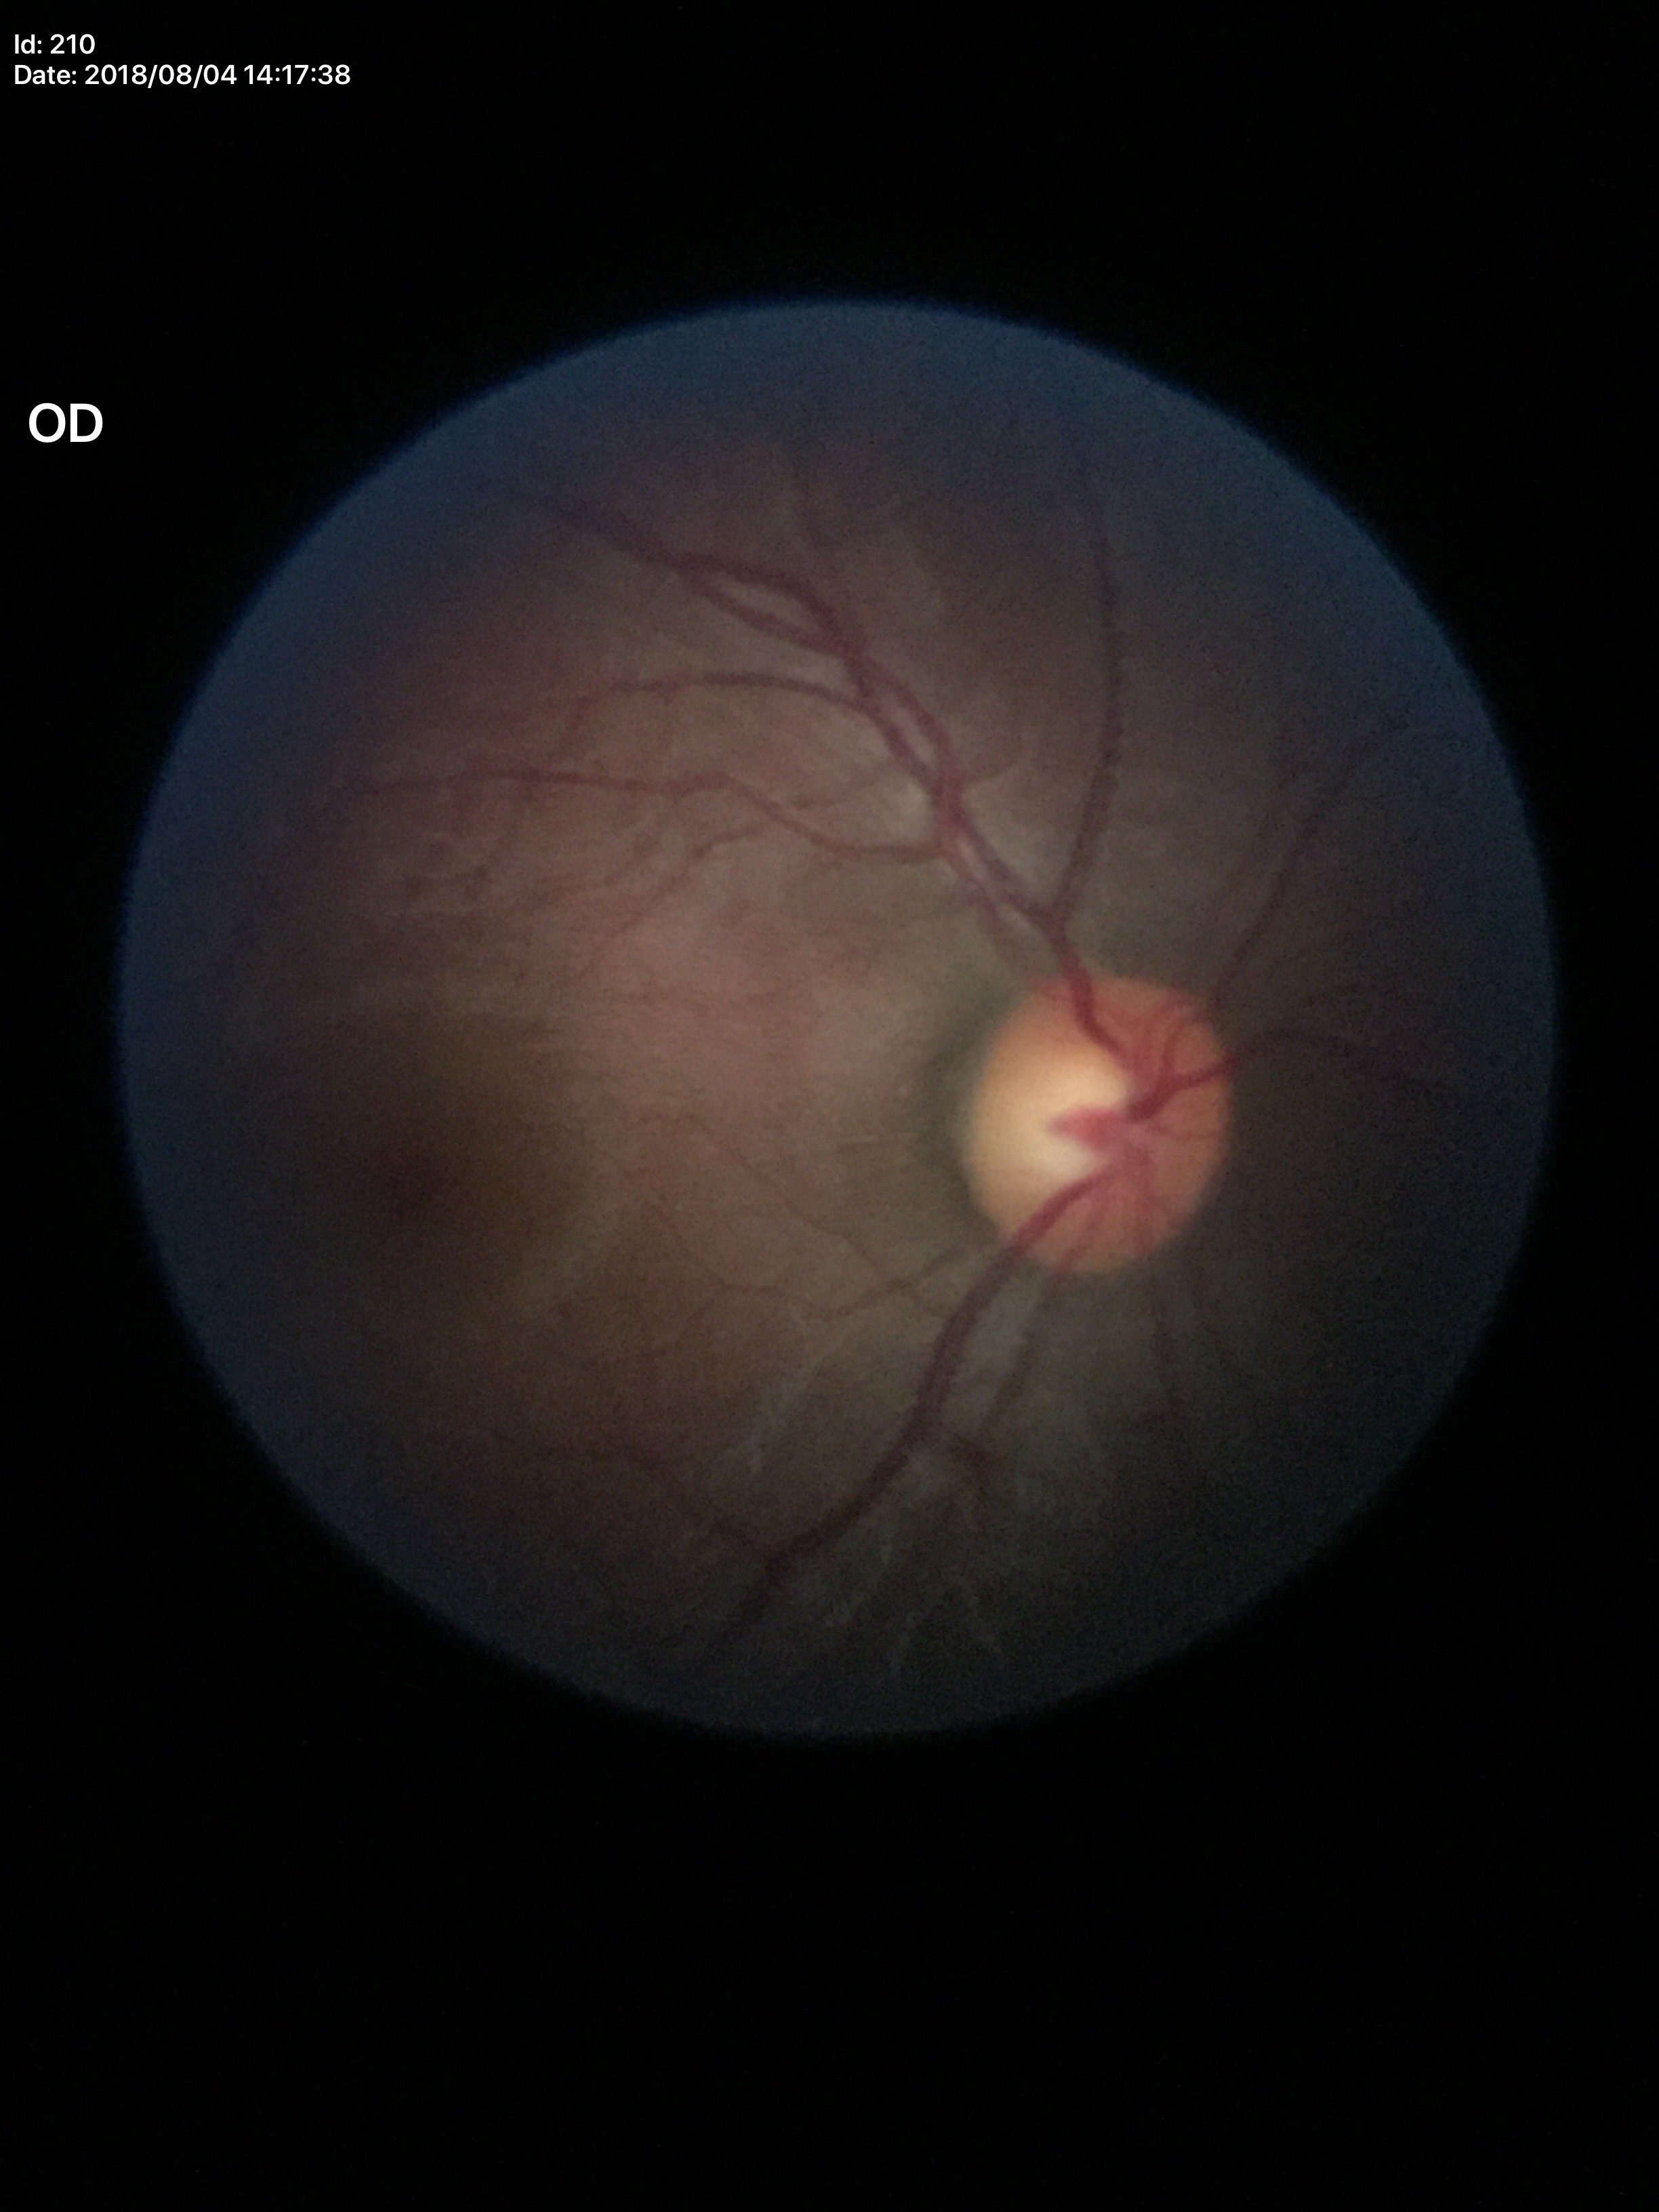
Glaucoma impression: negative.
HCDR is 0.56.
VCDR is 0.52.